Modified Davis classification.
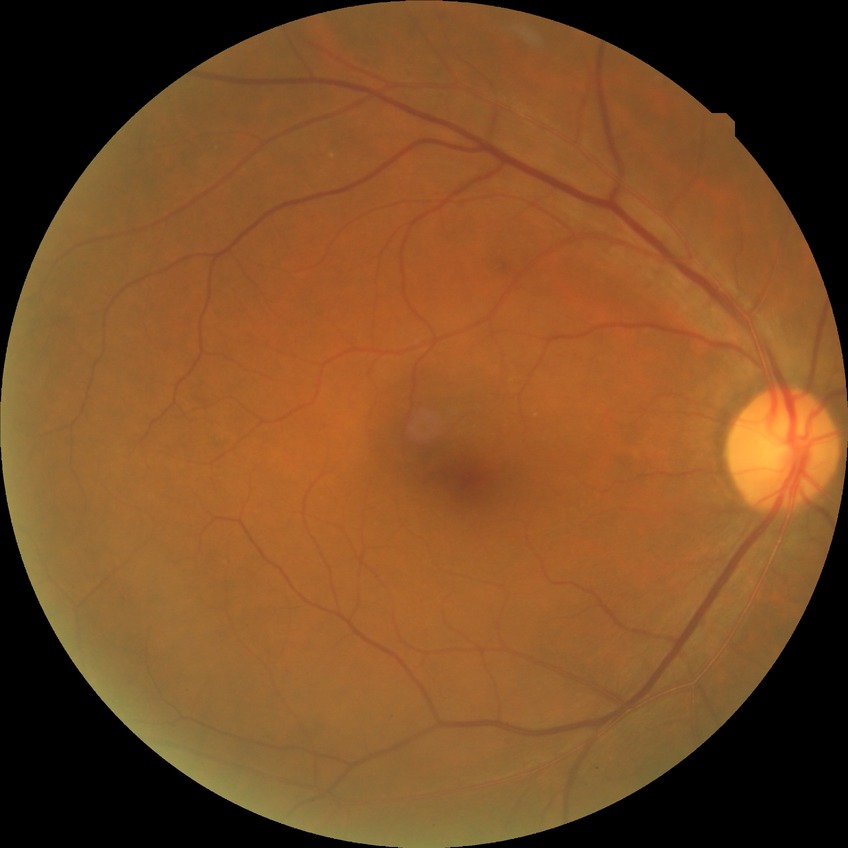 Diabetic retinopathy severity: simple diabetic retinopathy.